848x848px:
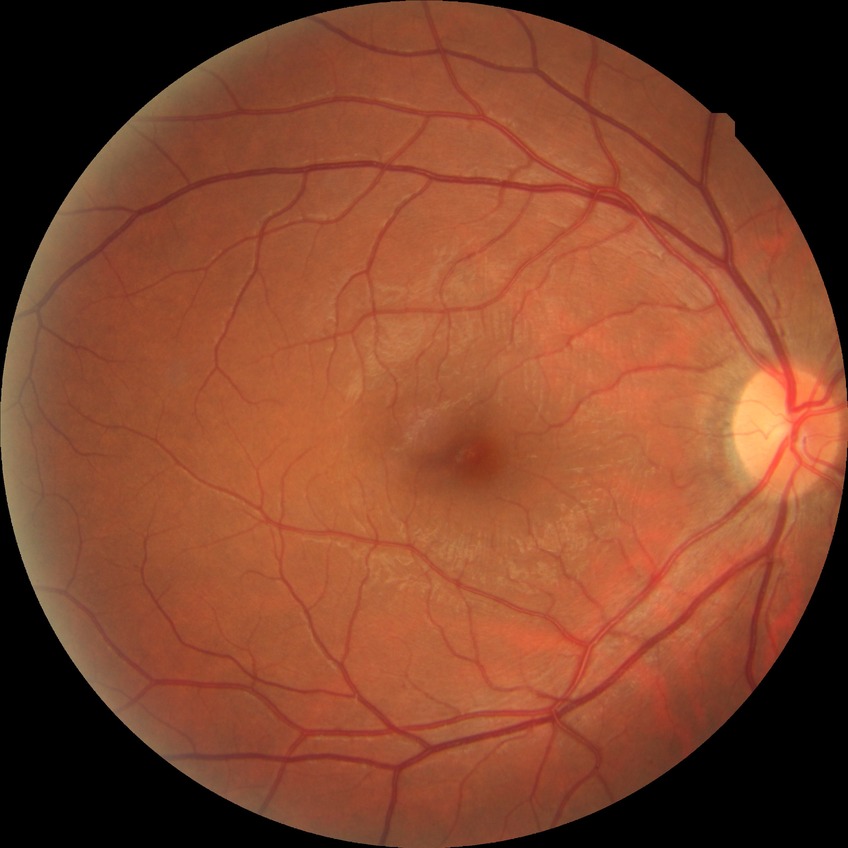 {
  "davis_grade": "simple diabetic retinopathy"
}